2352x1568px
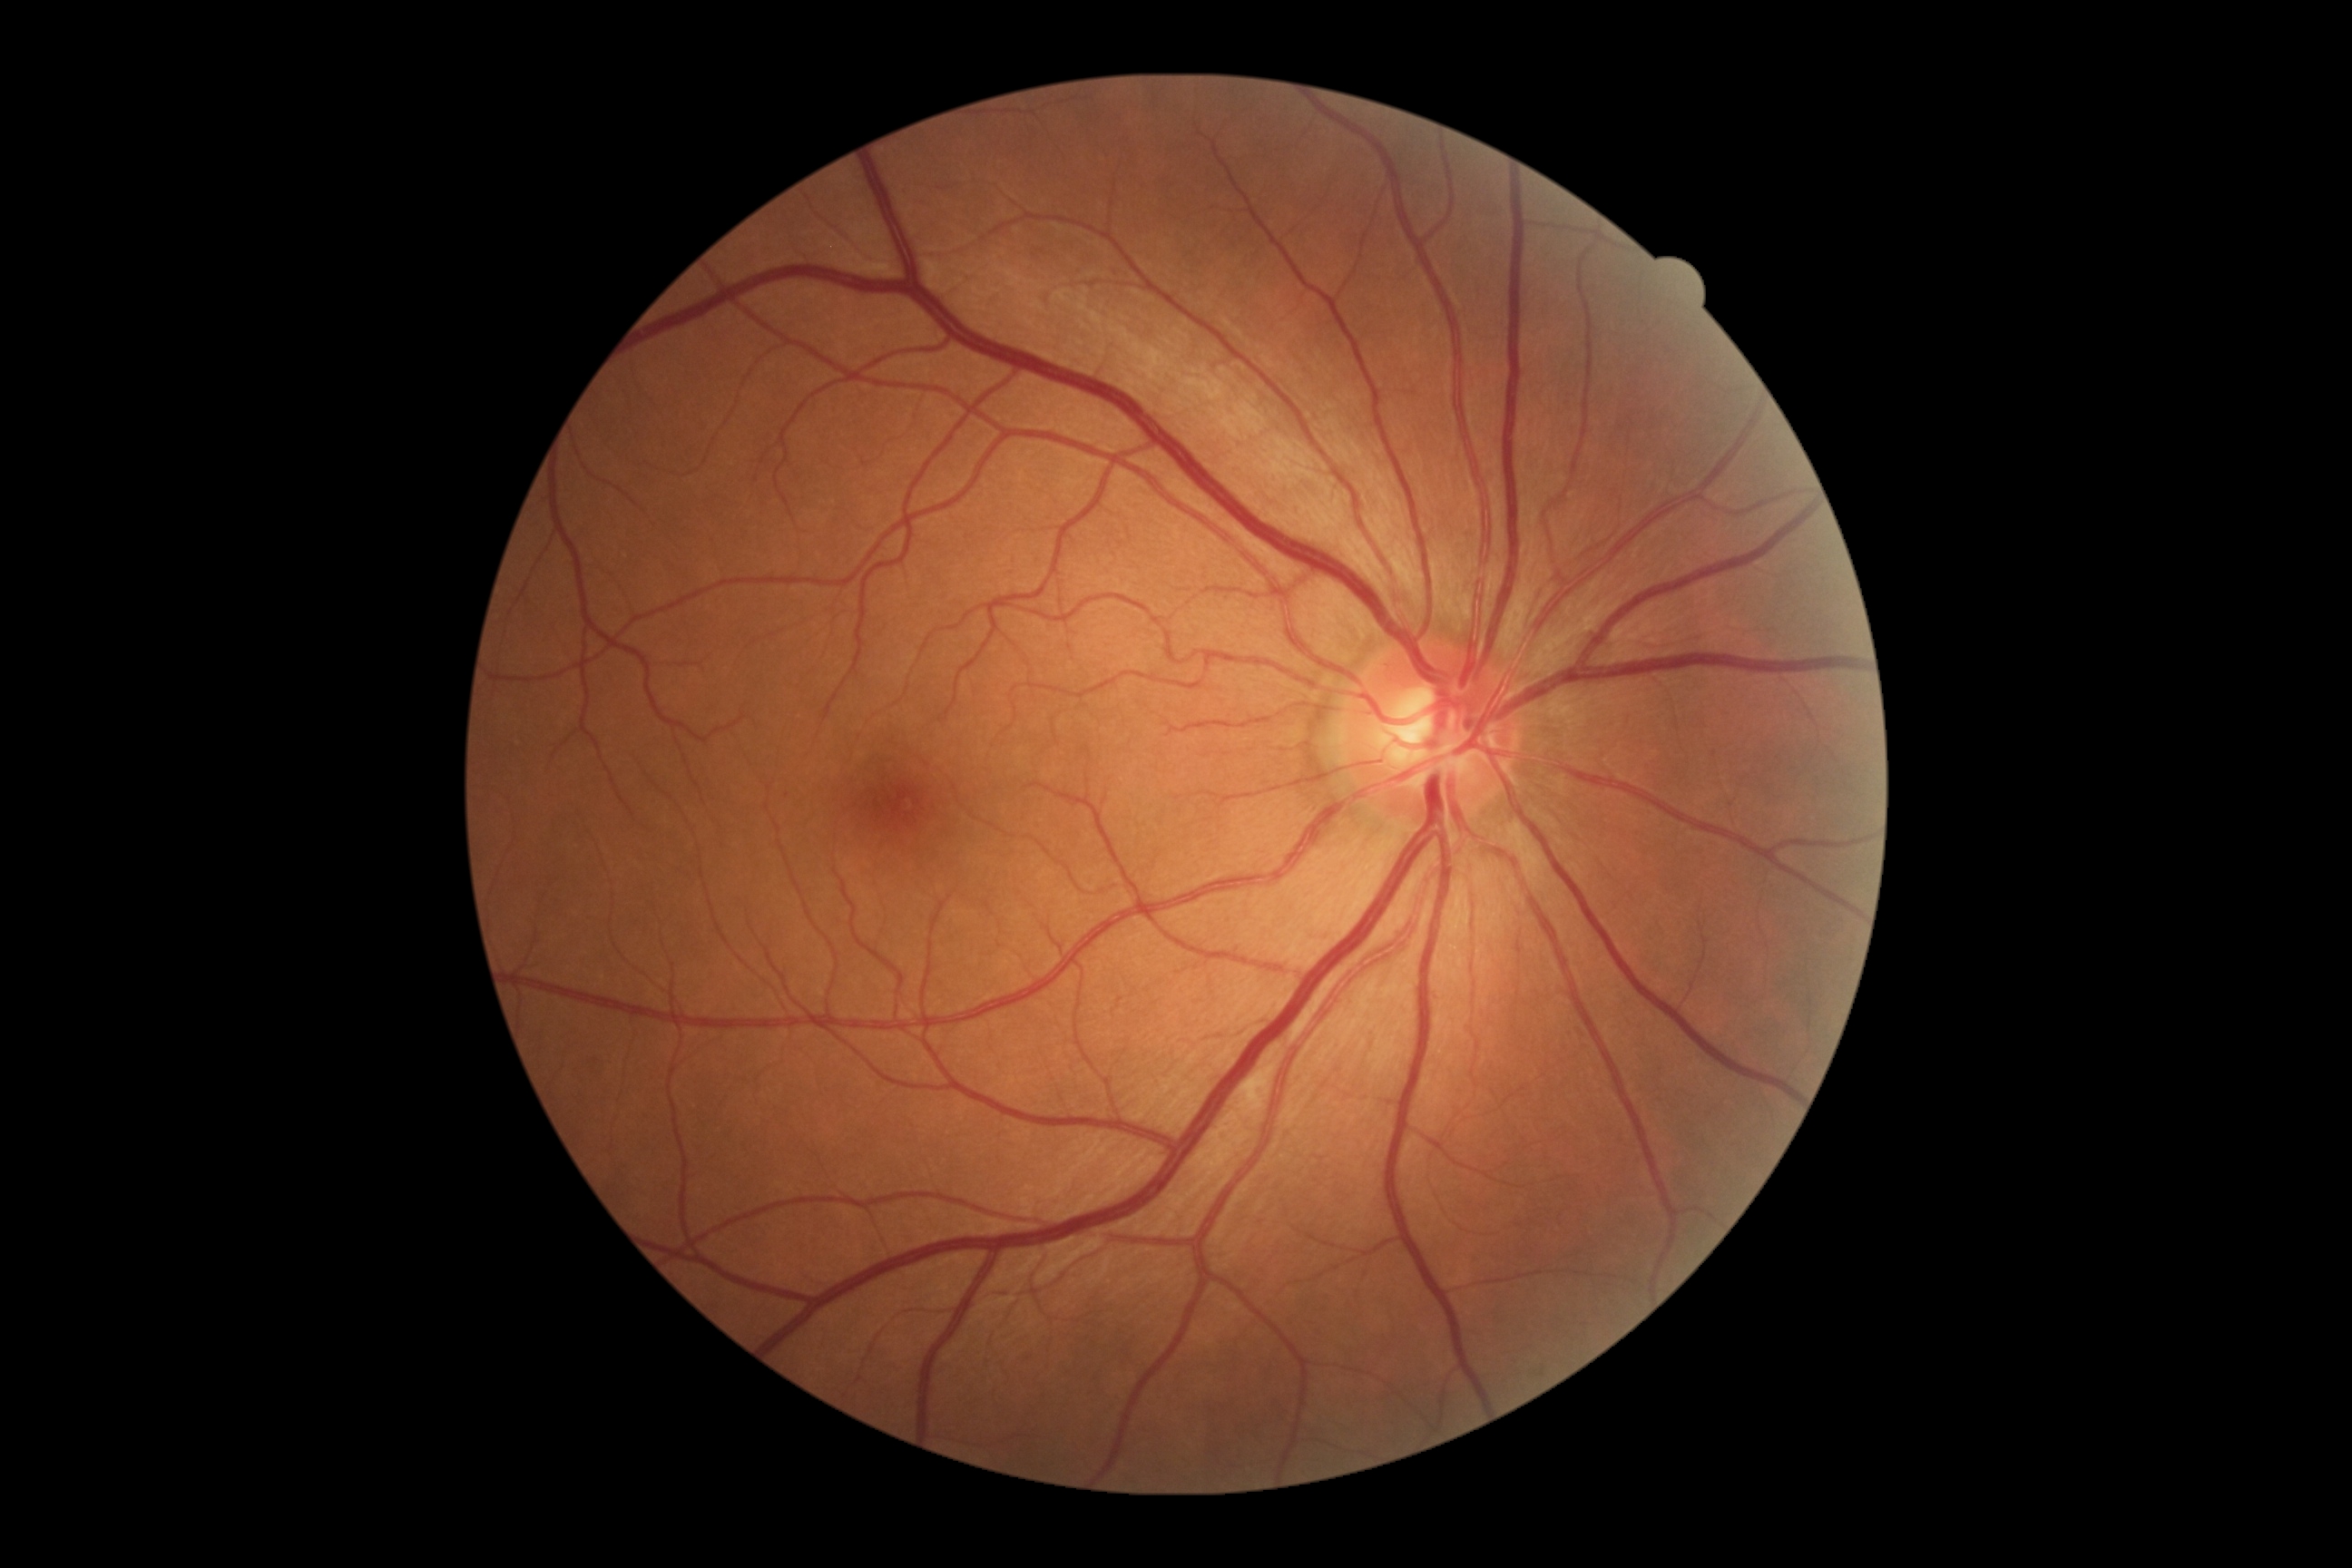
Diabetic retinopathy grade: moderate NPDR (2) — more than just microaneurysms but less than severe NPDR
soft exudates: none detected
hard exudates: none detected
Small microaneurysms near (788, 796)
hemorrhages: none detected